NIDEK AFC-230.
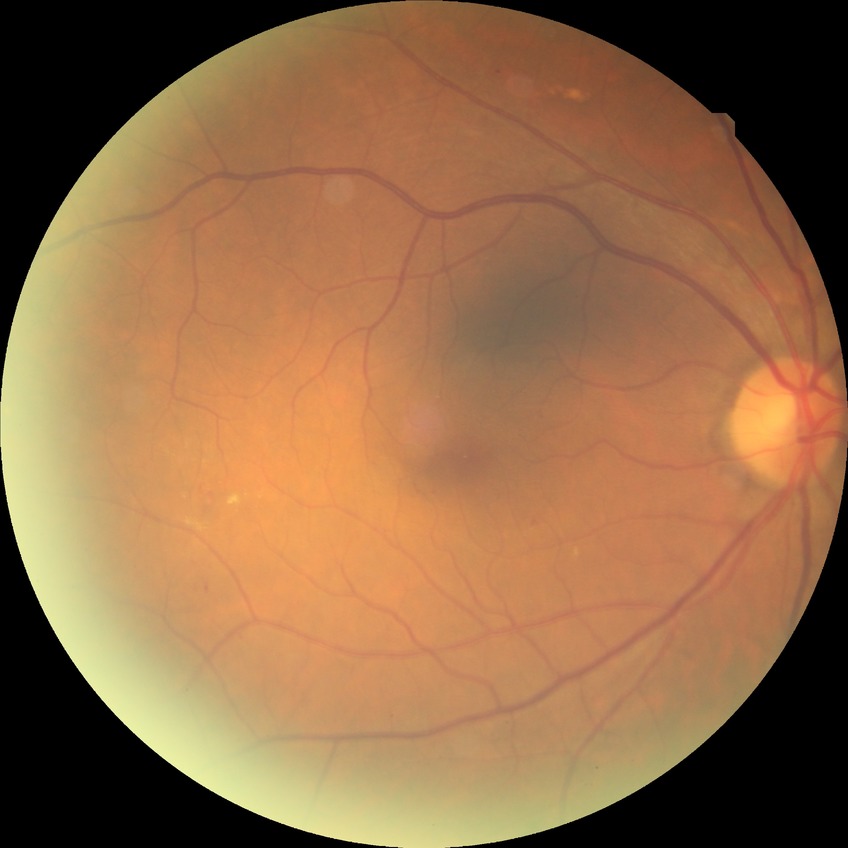

Davis grading is simple diabetic retinopathy.